NIDEK AFC-230; nonmydriatic; DR severity per modified Davis staging; posterior pole color fundus photograph
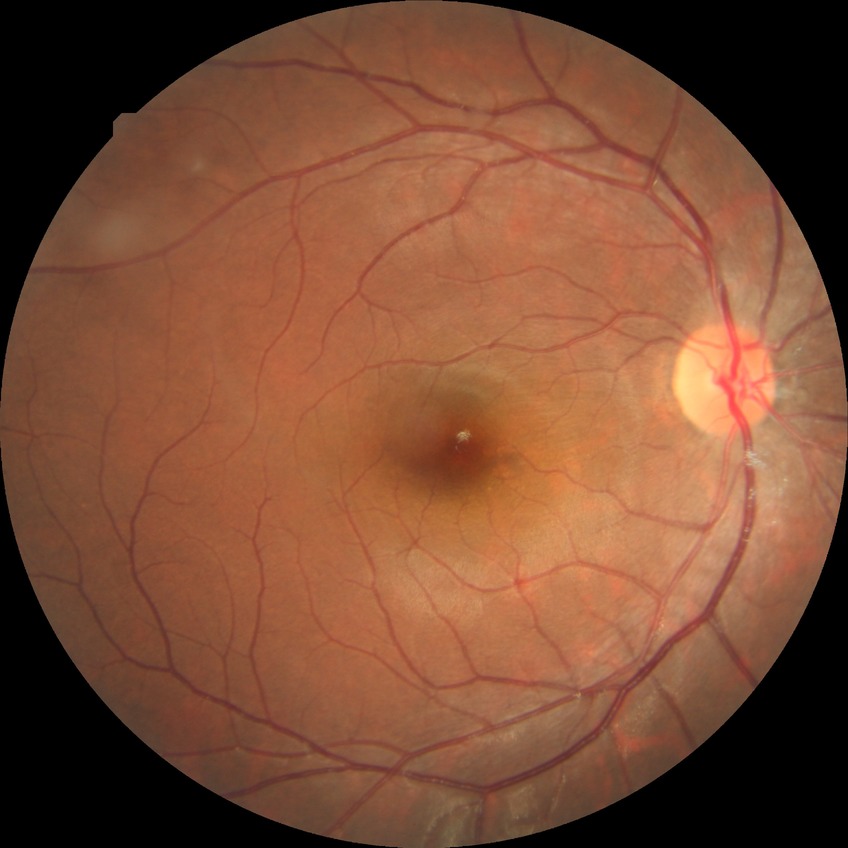

diabetic retinopathy (DR): no diabetic retinopathy (NDR)